Pediatric retinal photograph (wide-field).
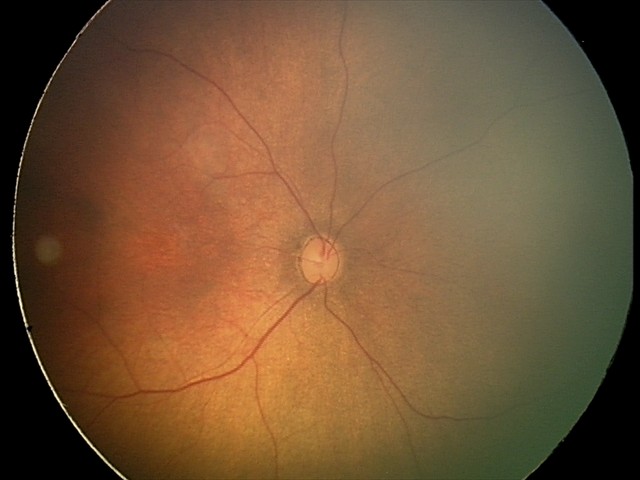

Screening: physiological appearance with no retinal pathology.